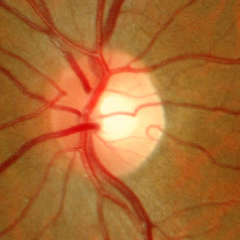
Glaucoma status = no signs of glaucoma.